848x848px, posterior pole photograph, NIDEK AFC-230 fundus camera, 45° FOV, no pharmacologic dilation
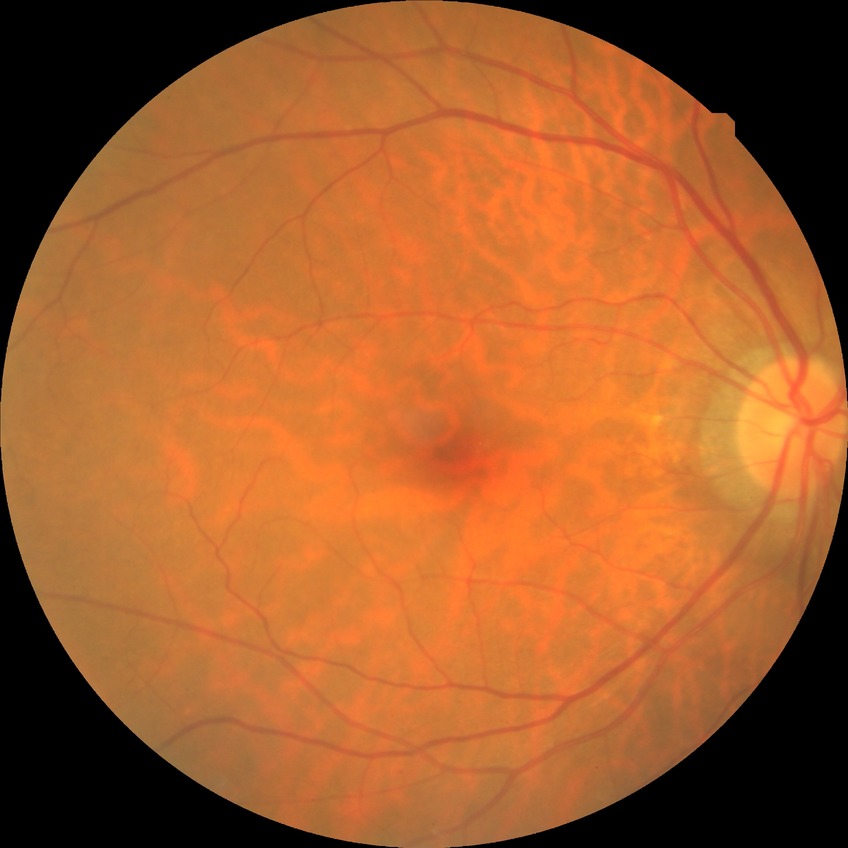

Diabetic retinopathy (DR): NDR (no diabetic retinopathy).